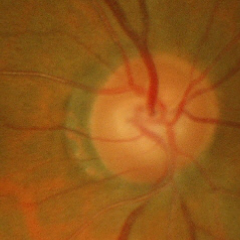
Fundus appearance consistent with early glaucoma. (Criteria: glaucomatous retinal nerve fiber layer defects on red-free fundus photography without visual field defects.)